Retinal fundus photograph: 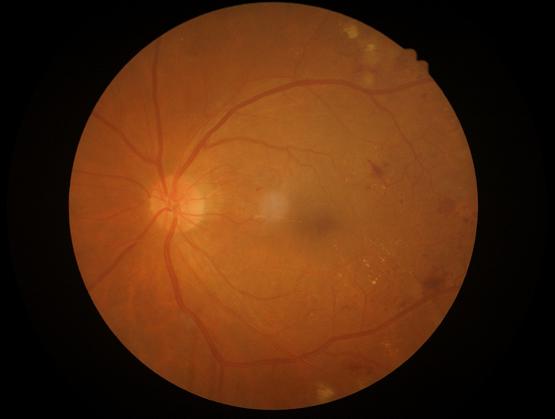

Even illumination with no color cast. Image is sharp throughout the field. Overall image quality is good.